848x848; without pupil dilation; posterior pole photograph — 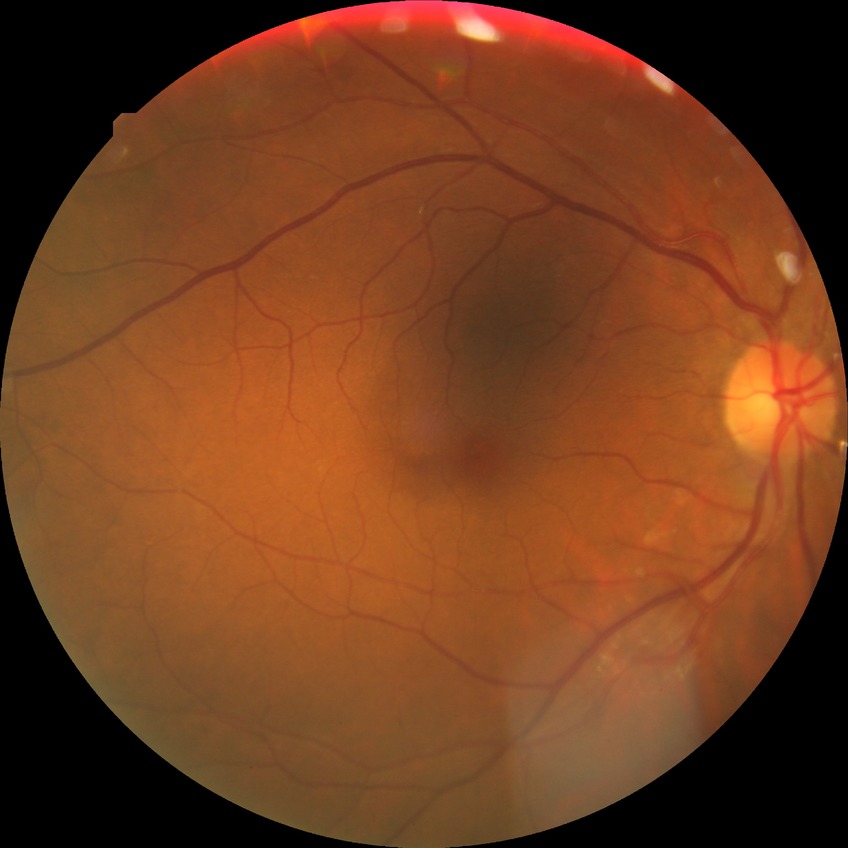
Modified Davis grade: SDR.